CFP · 1932x1910px: 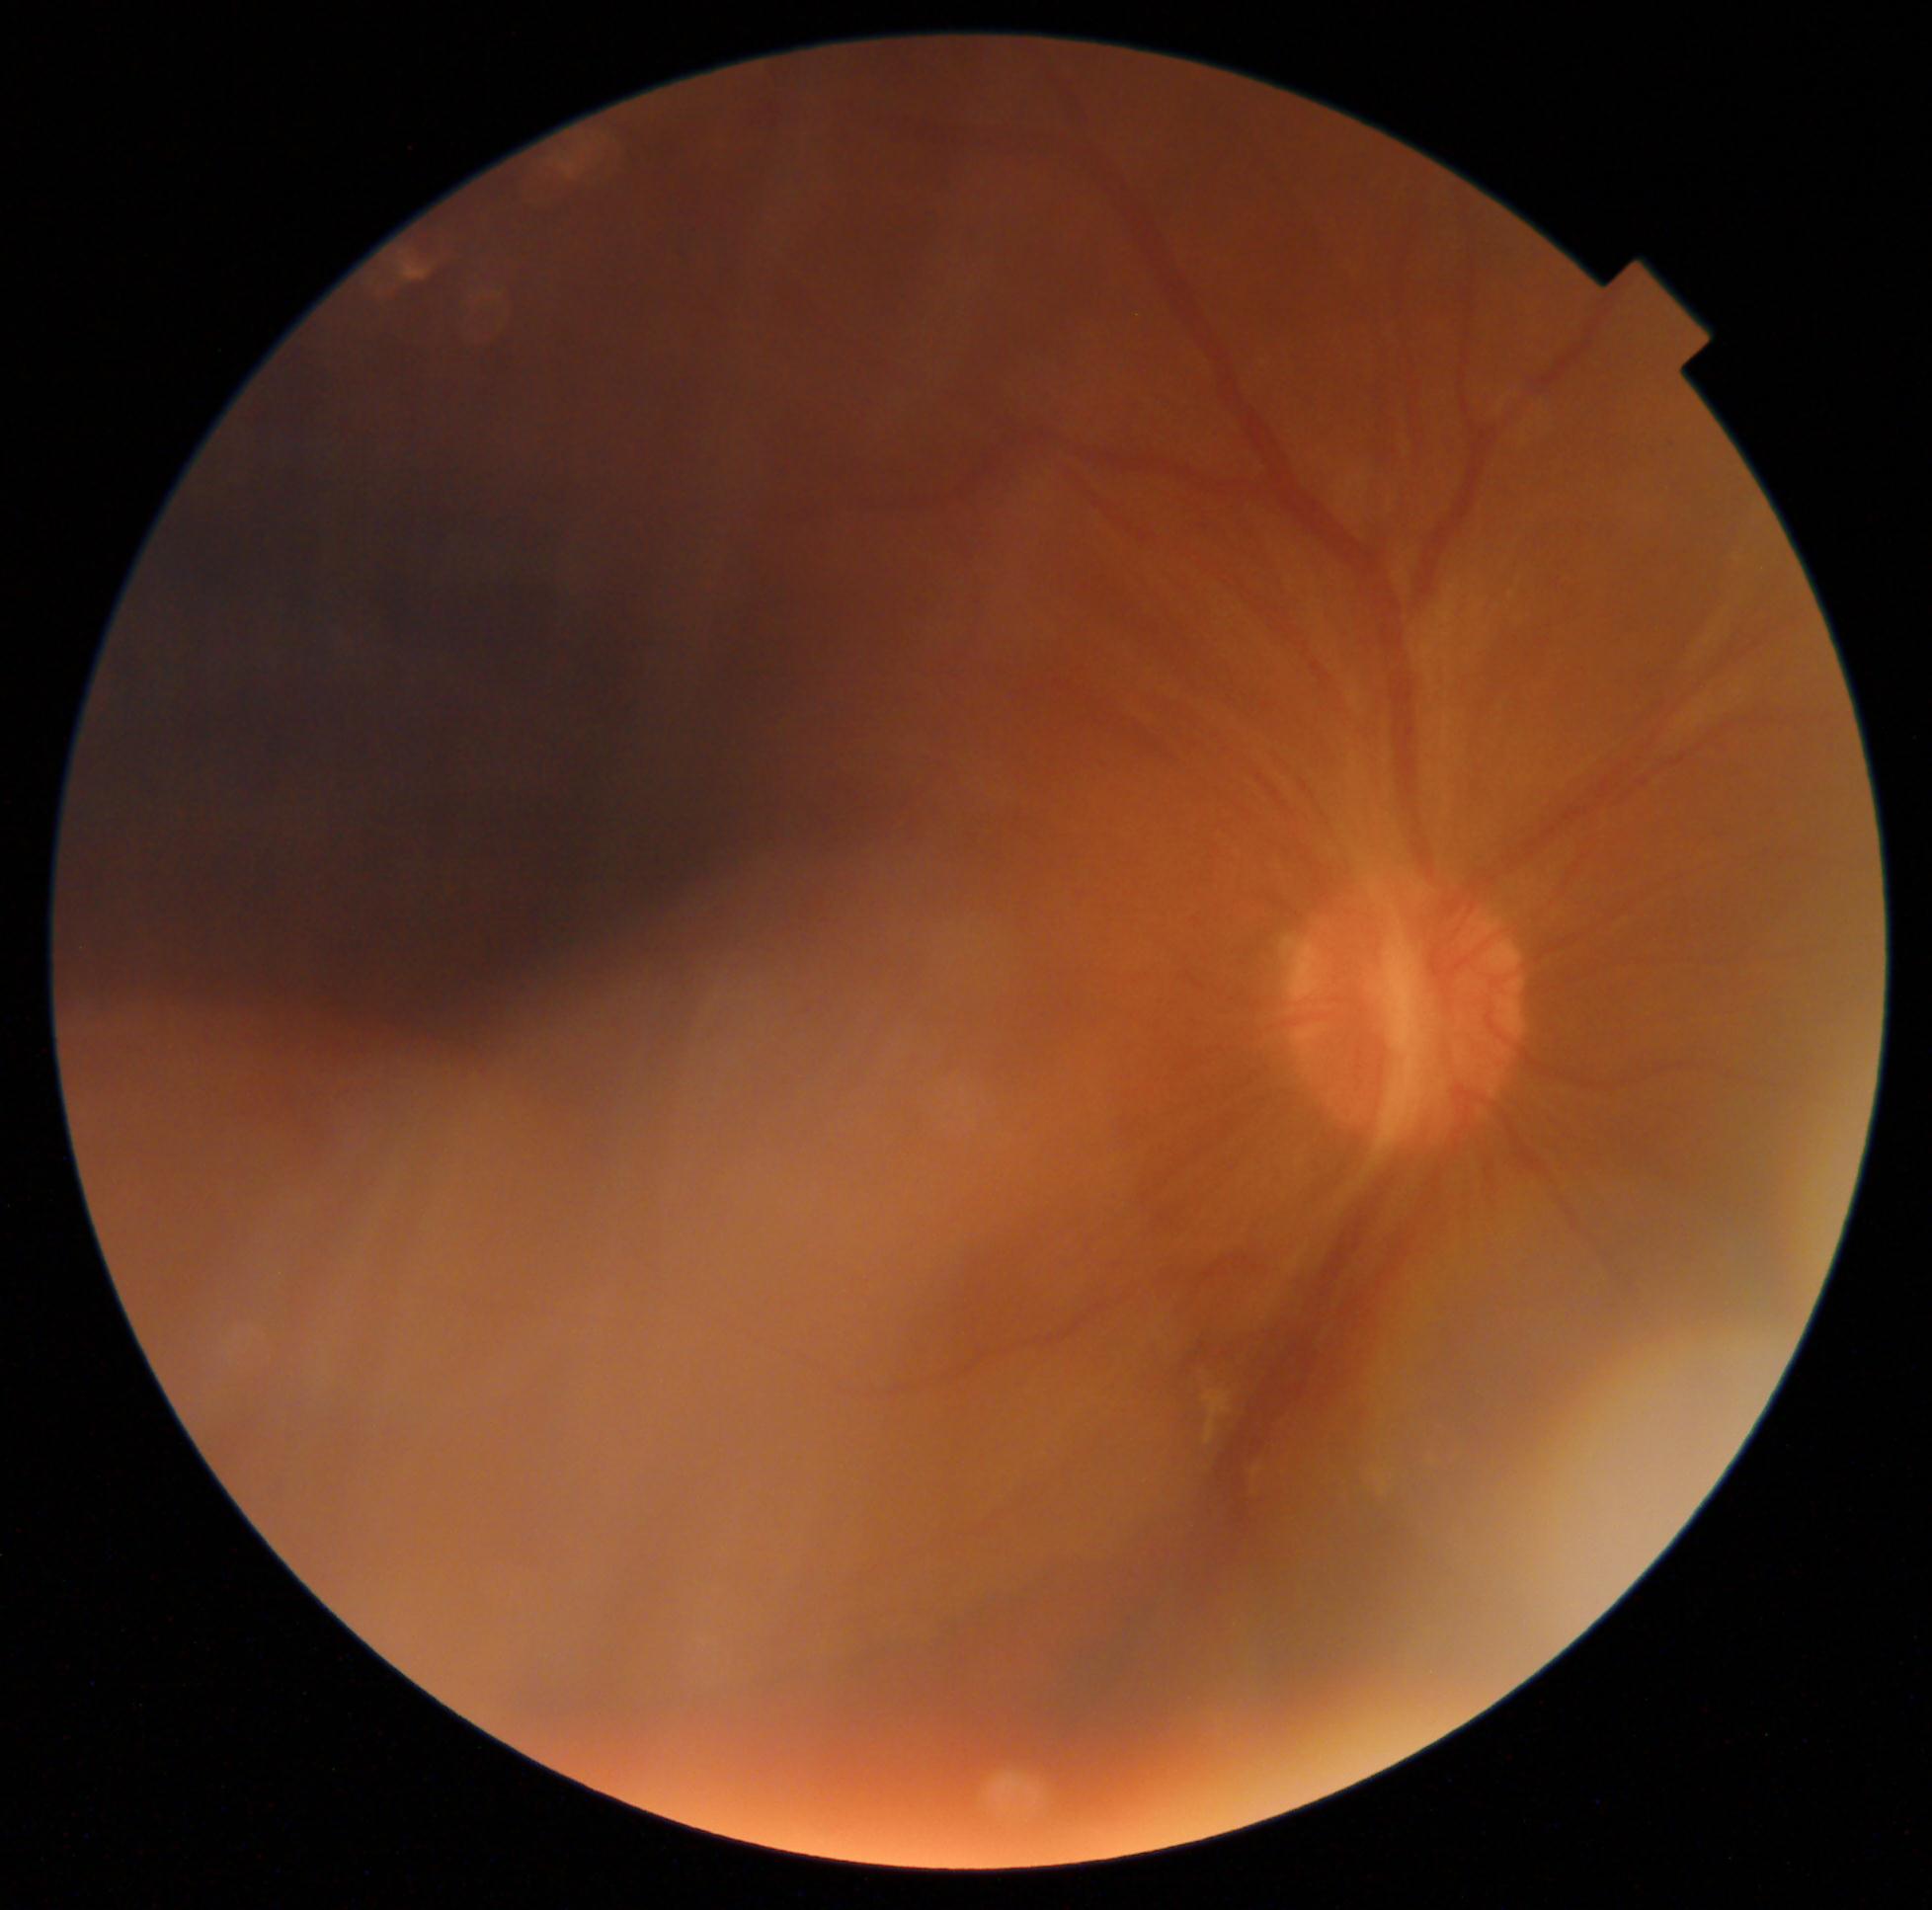
Disease class: proliferative diabetic retinopathy.
DR stage is grade 4 — neovascularization and/or vitreous/pre-retinal hemorrhage.